RetCam wide-field infant fundus image: 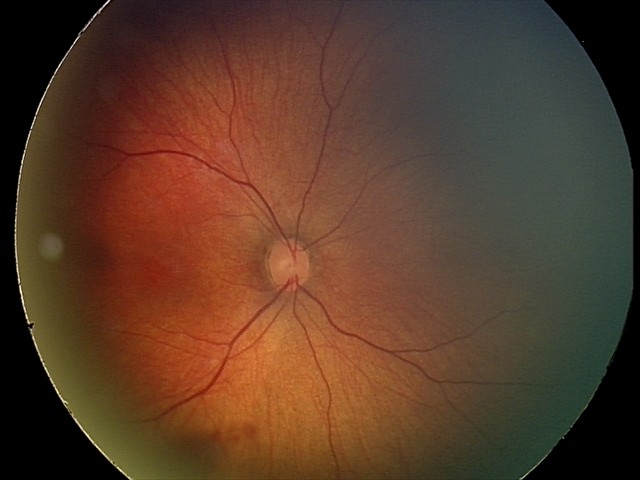
Series diagnosed as retinal hemorrhages.